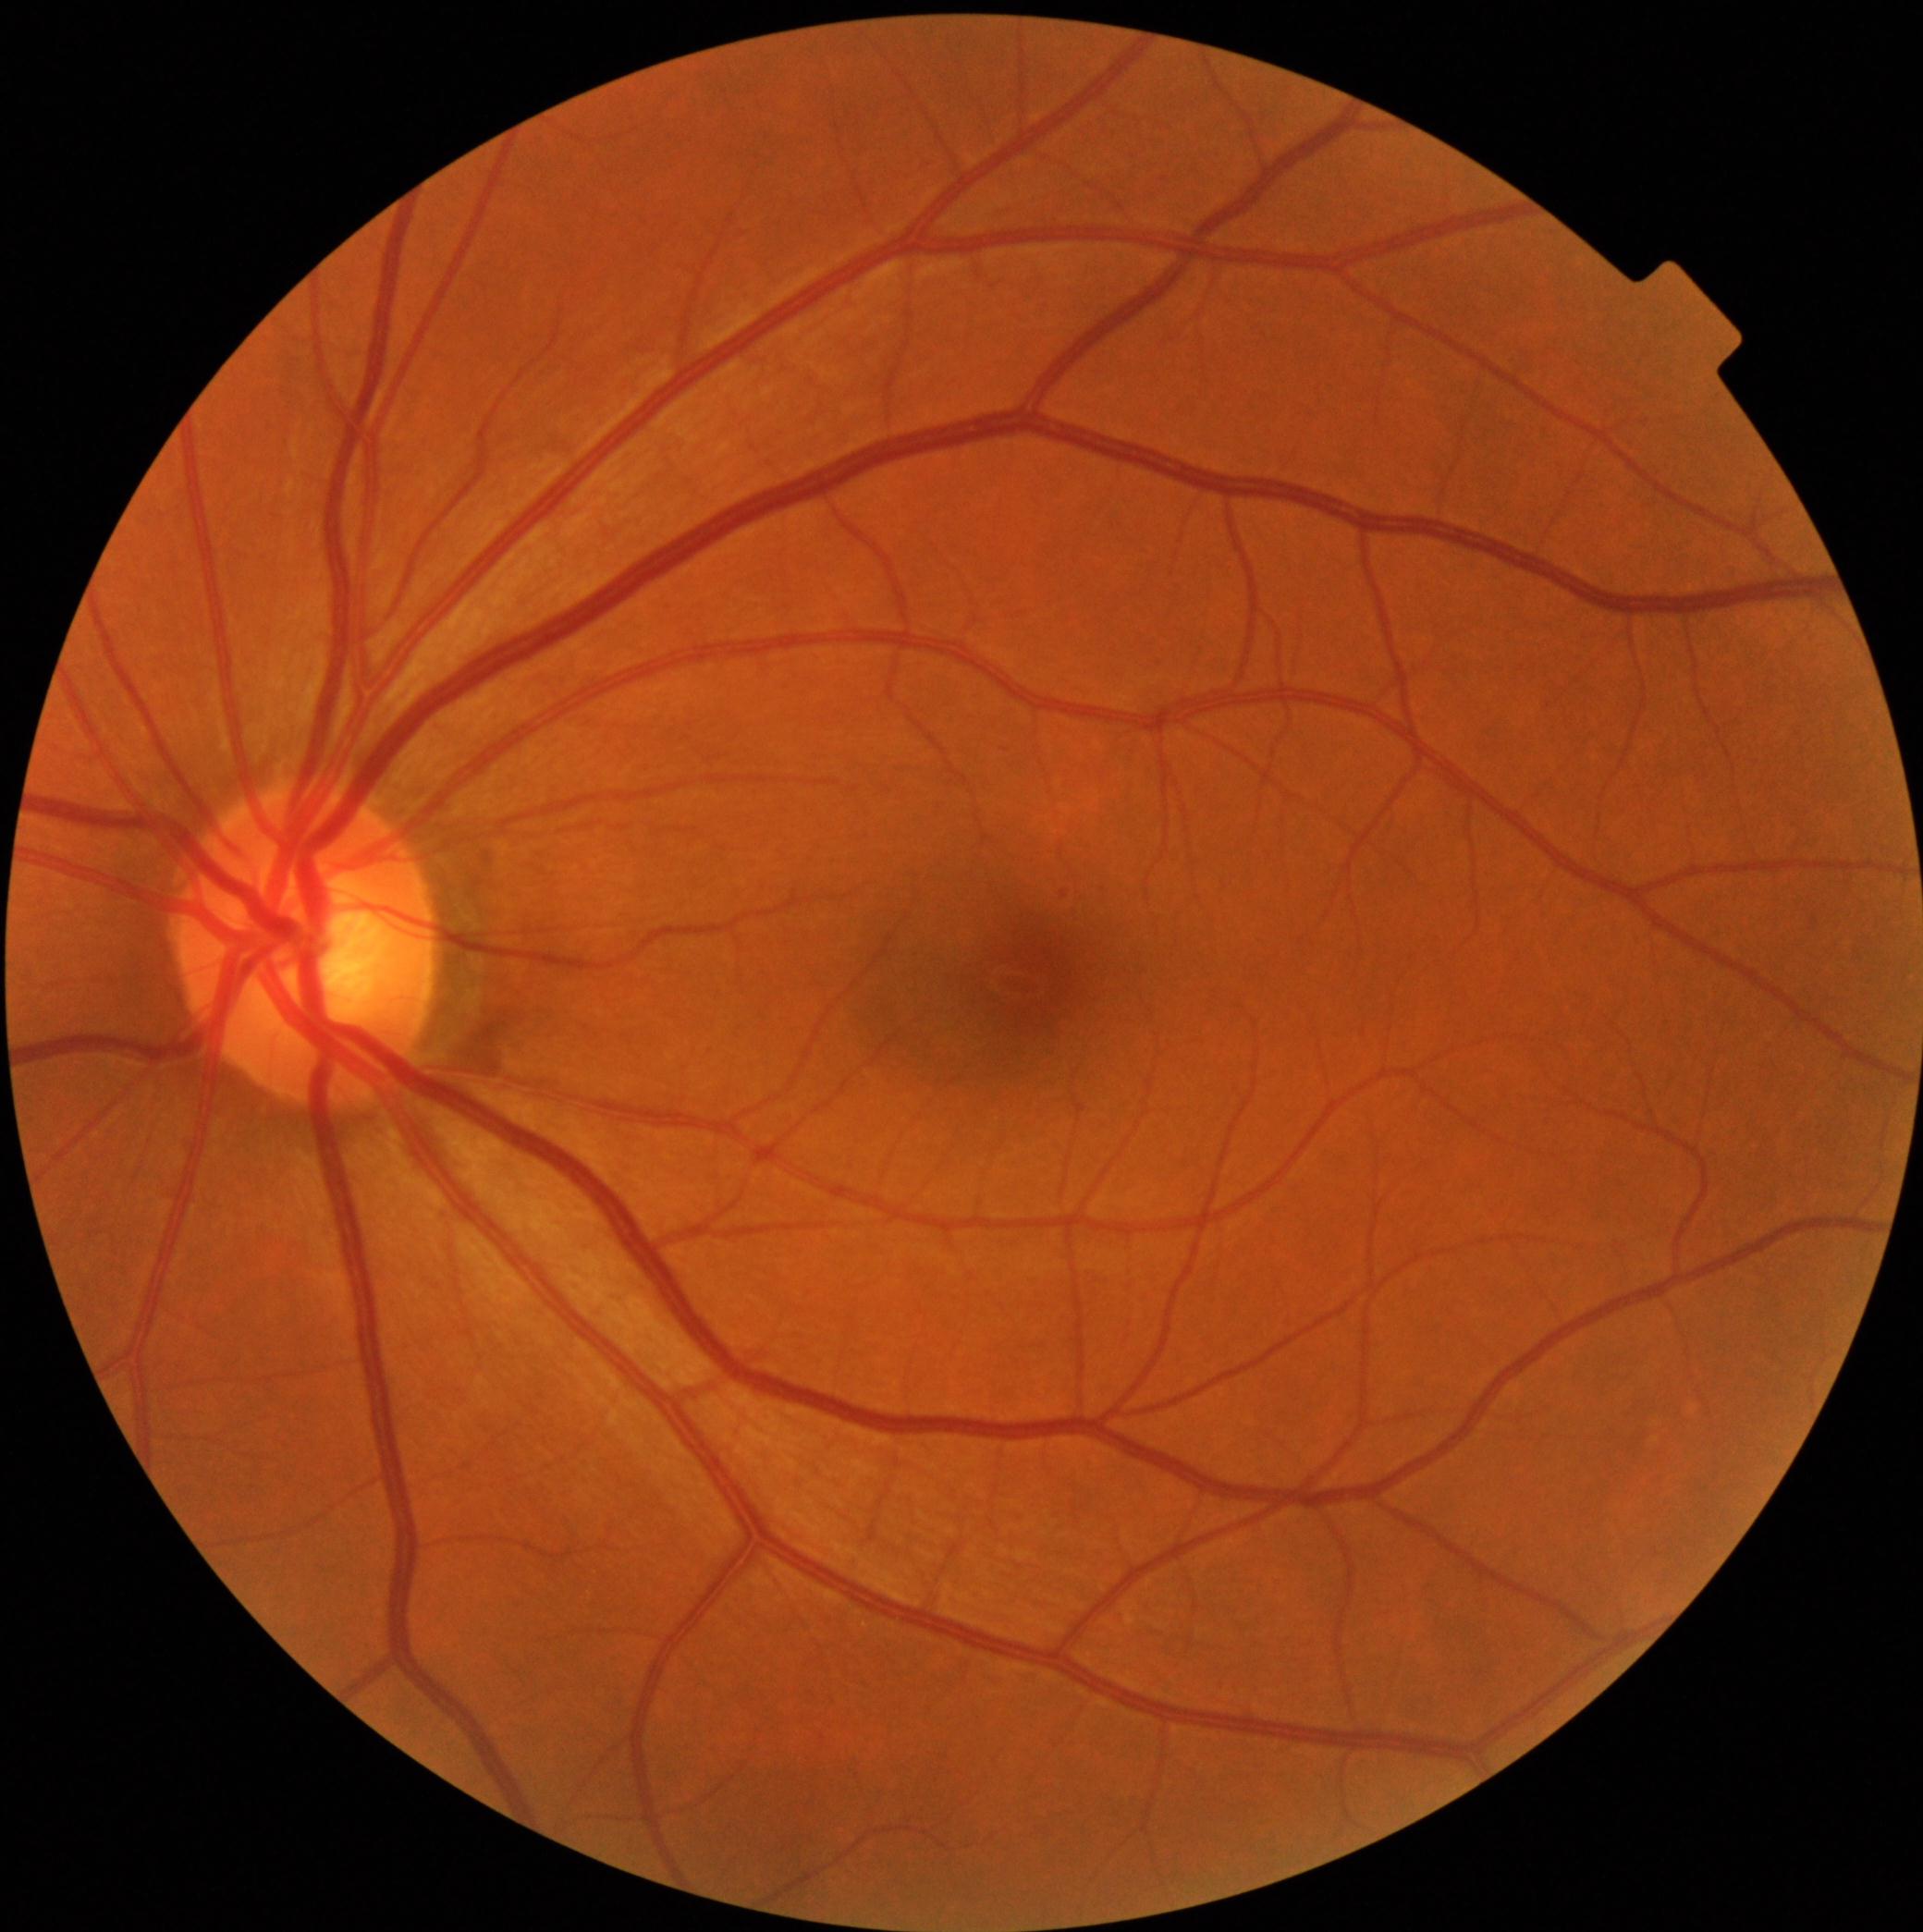

DR class: non-proliferative diabetic retinopathy.
DR is grade 1 — presence of microaneurysms only.